848 by 848 pixels. Retinal fundus photograph. Nonmydriatic. Camera: NIDEK AFC-230
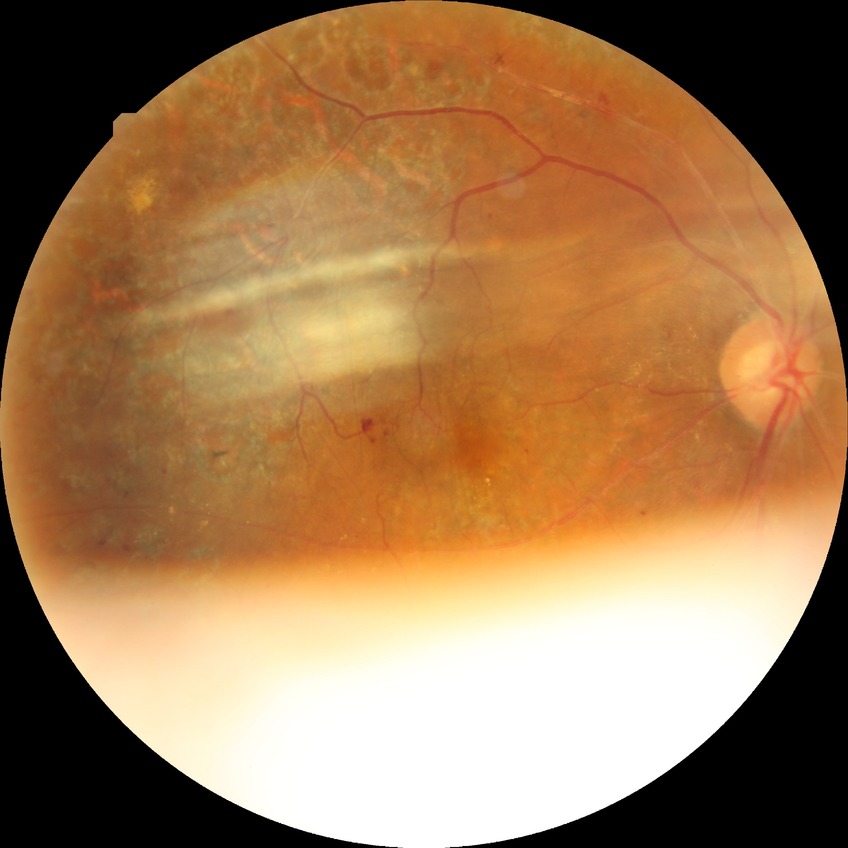

diabetic retinopathy (DR): proliferative diabetic retinopathy (PDR).